Without pupil dilation · acquired with a NIDEK AFC-230: 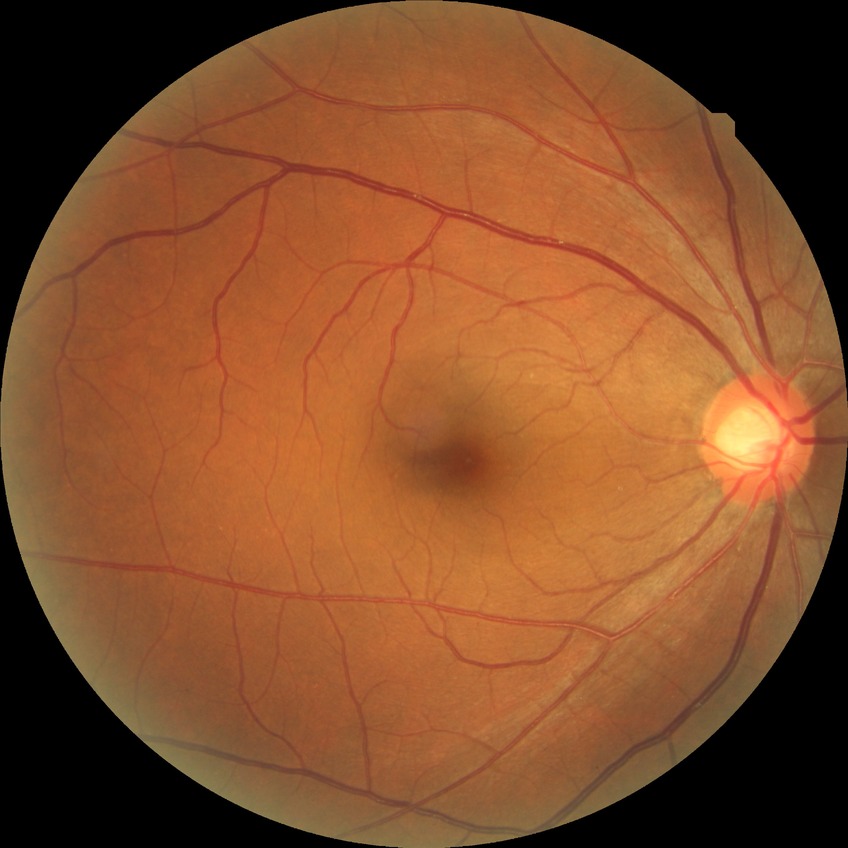

DR stage: NDR.
No apparent diabetic retinopathy.